640x480px · acquired on the Clarity RetCam 3 · wide-field fundus image from infant ROP screening.
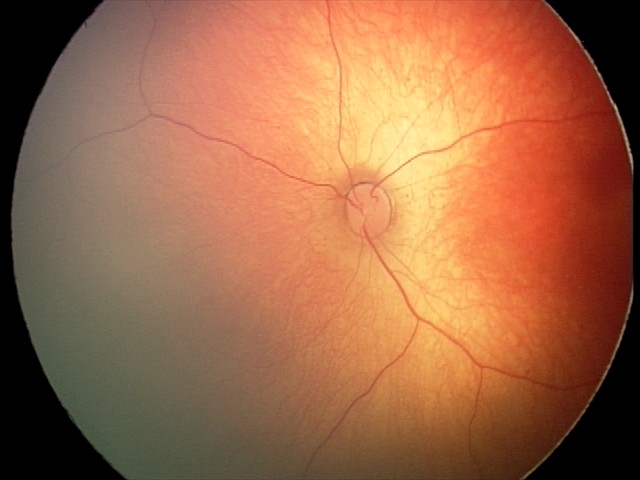 Screening diagnosis: physiological appearance with no retinal pathology.